Davis DR grading
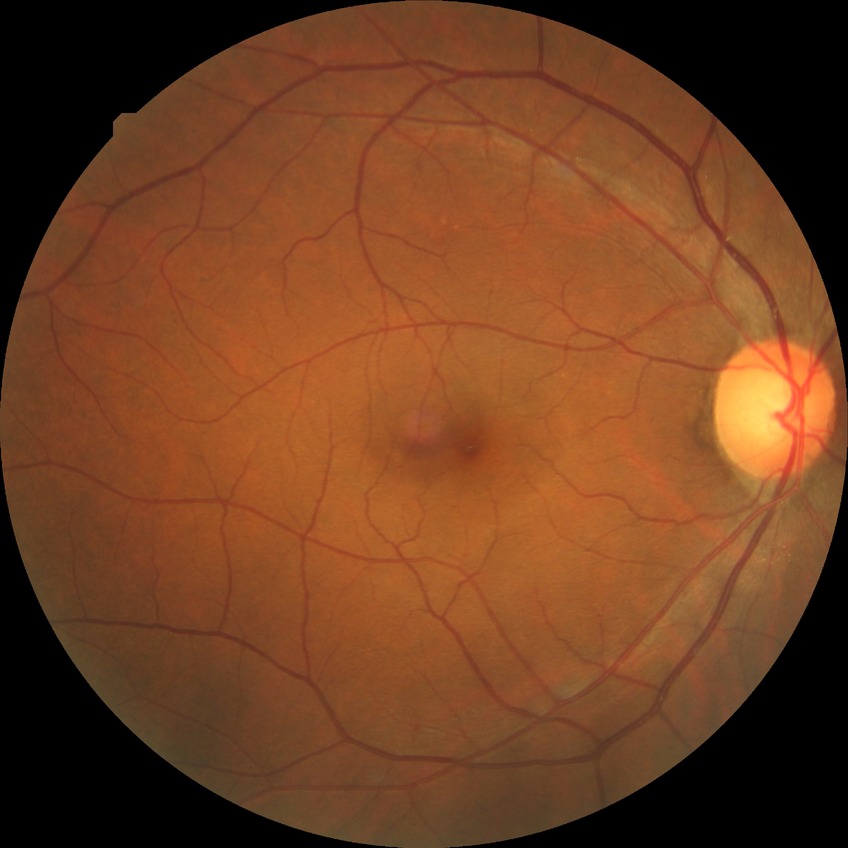   davis_grade: no diabetic retinopathy